Davis DR grading:
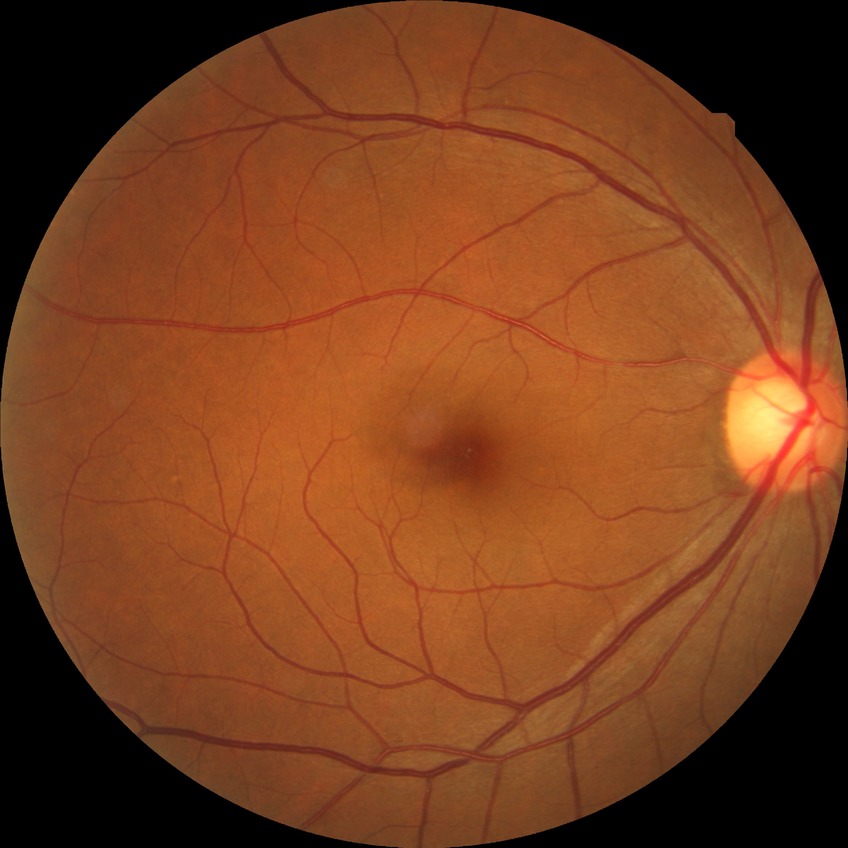

Modified Davis grading: no diabetic retinopathy.